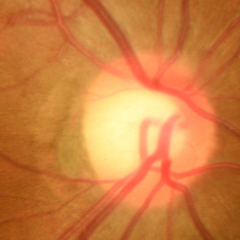

Glaucoma diagnosis: no glaucomatous changes.